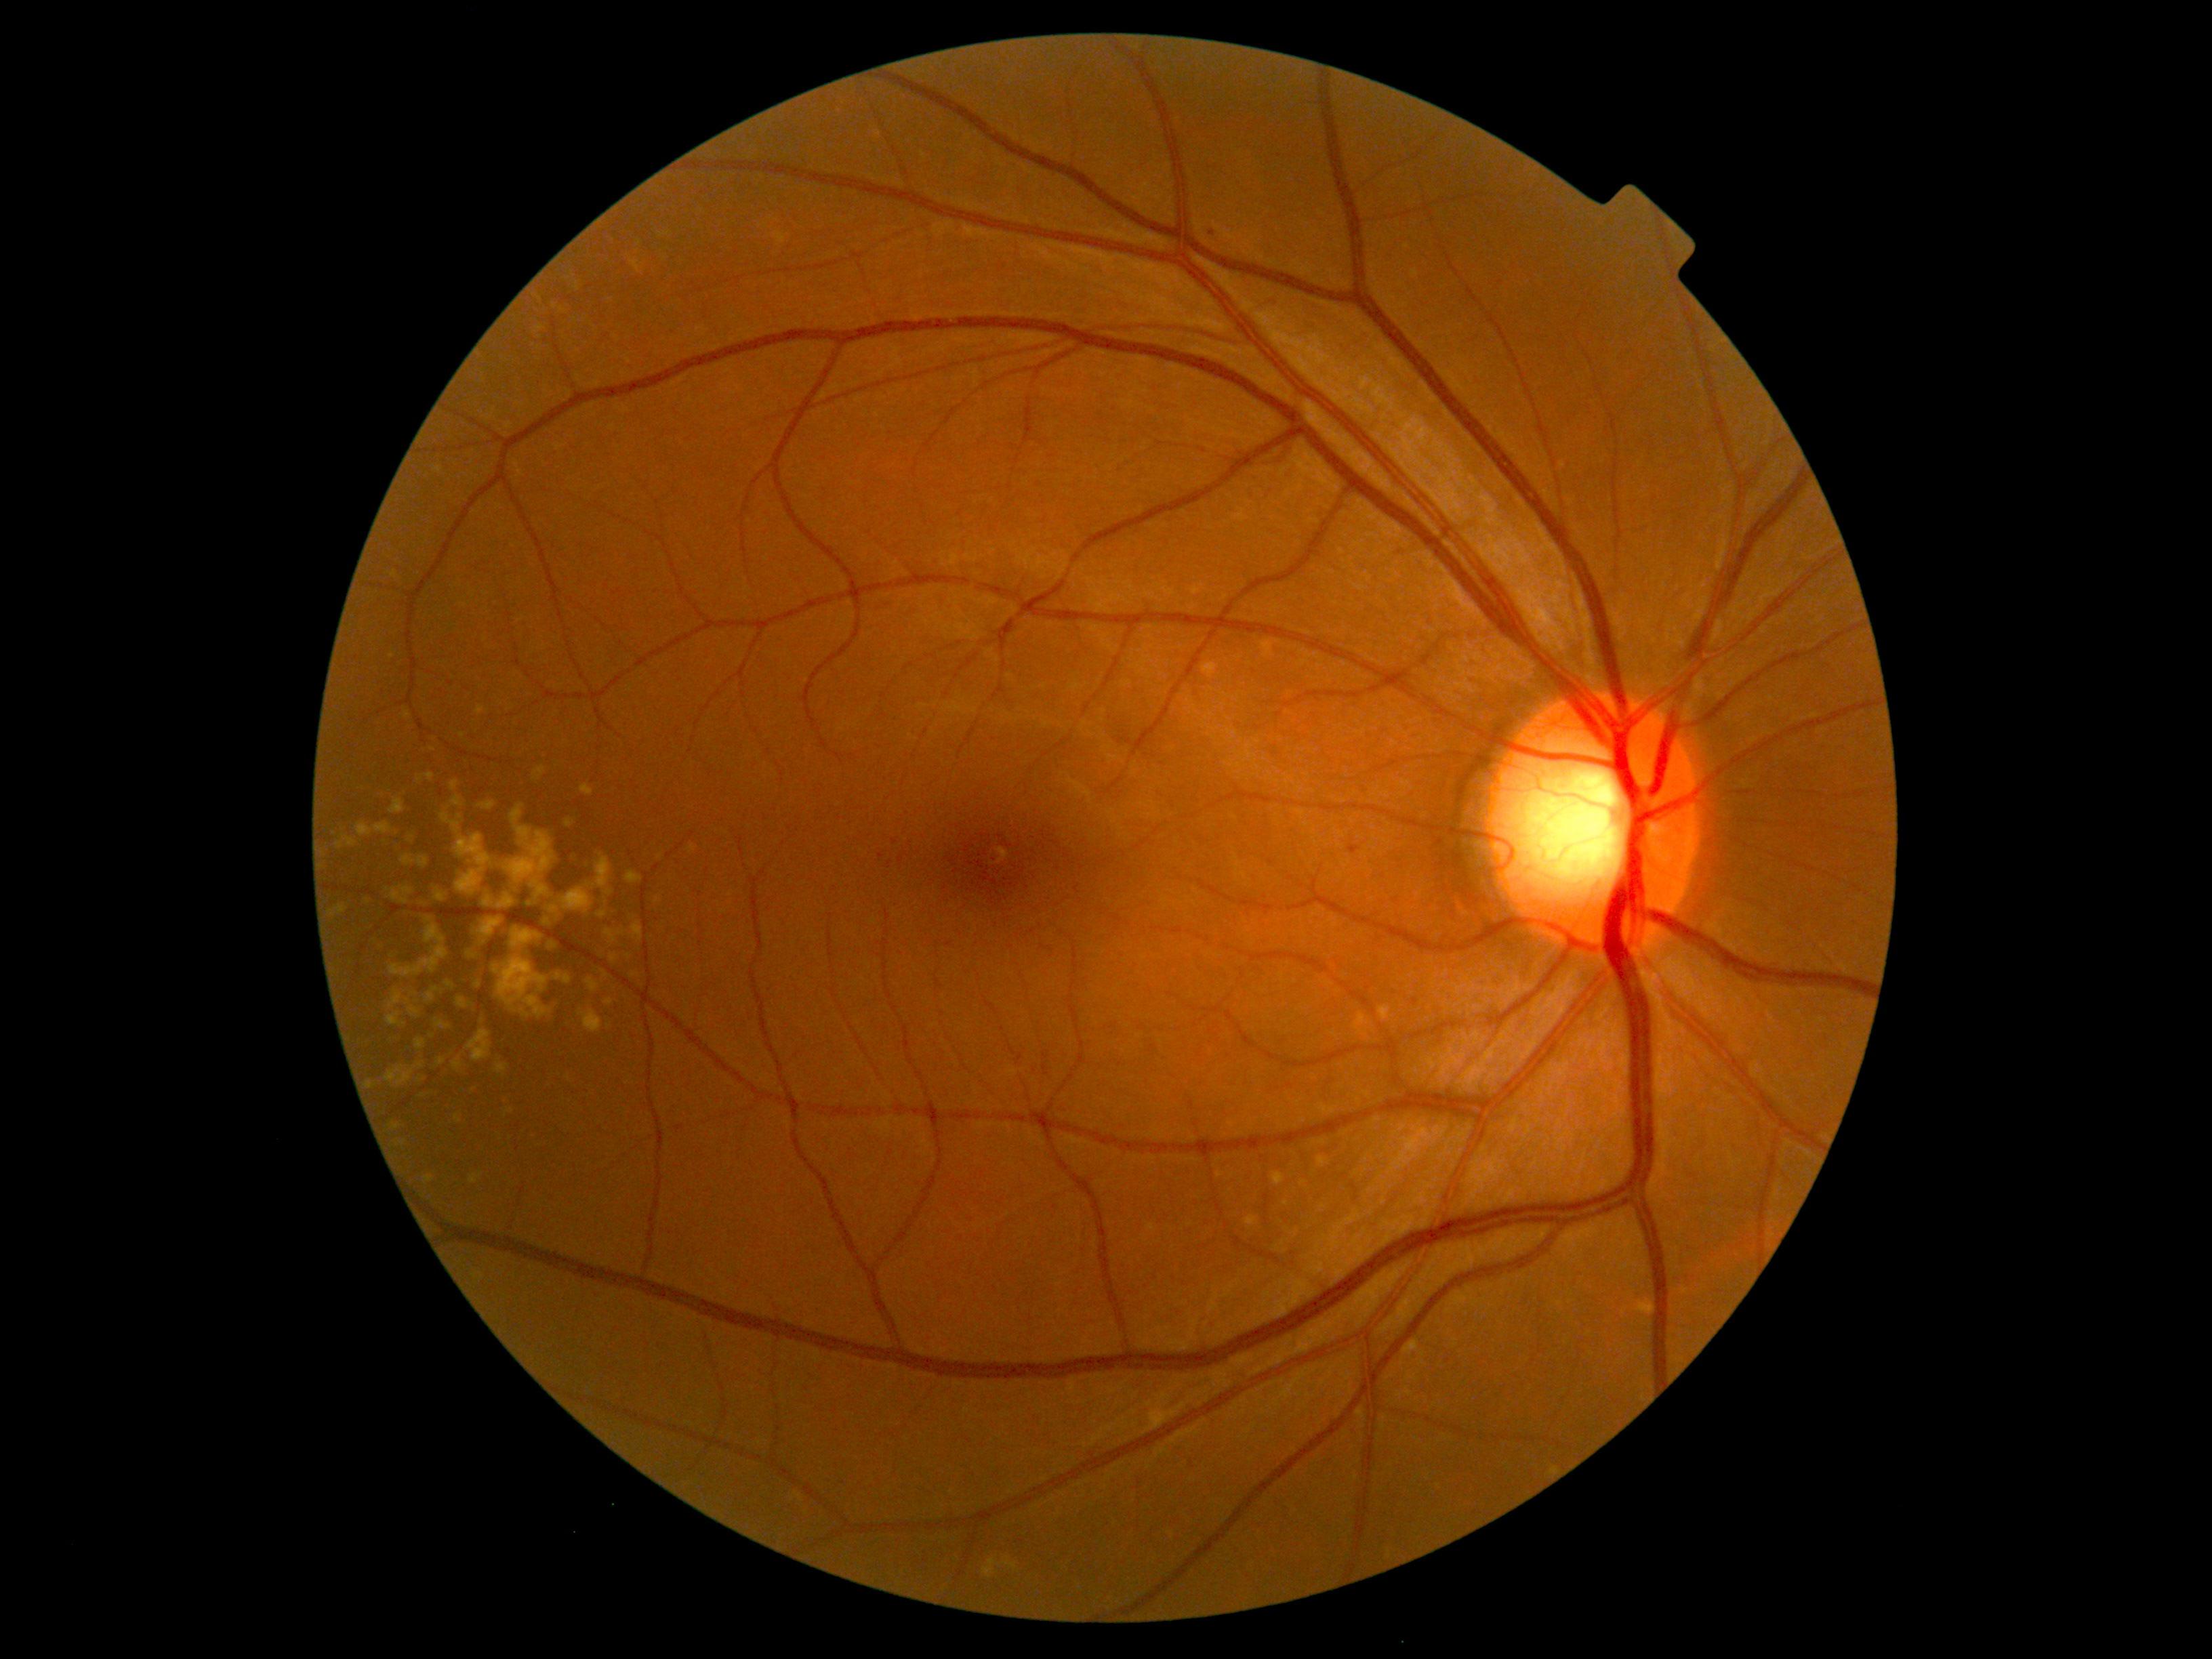
Retinopathy: grade 1
- hemorrhages: none detected
- hard exudates: none detected
- soft exudates: none detected
- microaneurysms: 1348,845,1360,855
- Microaneurysms (small, approximate centers) near pt(1212, 234)